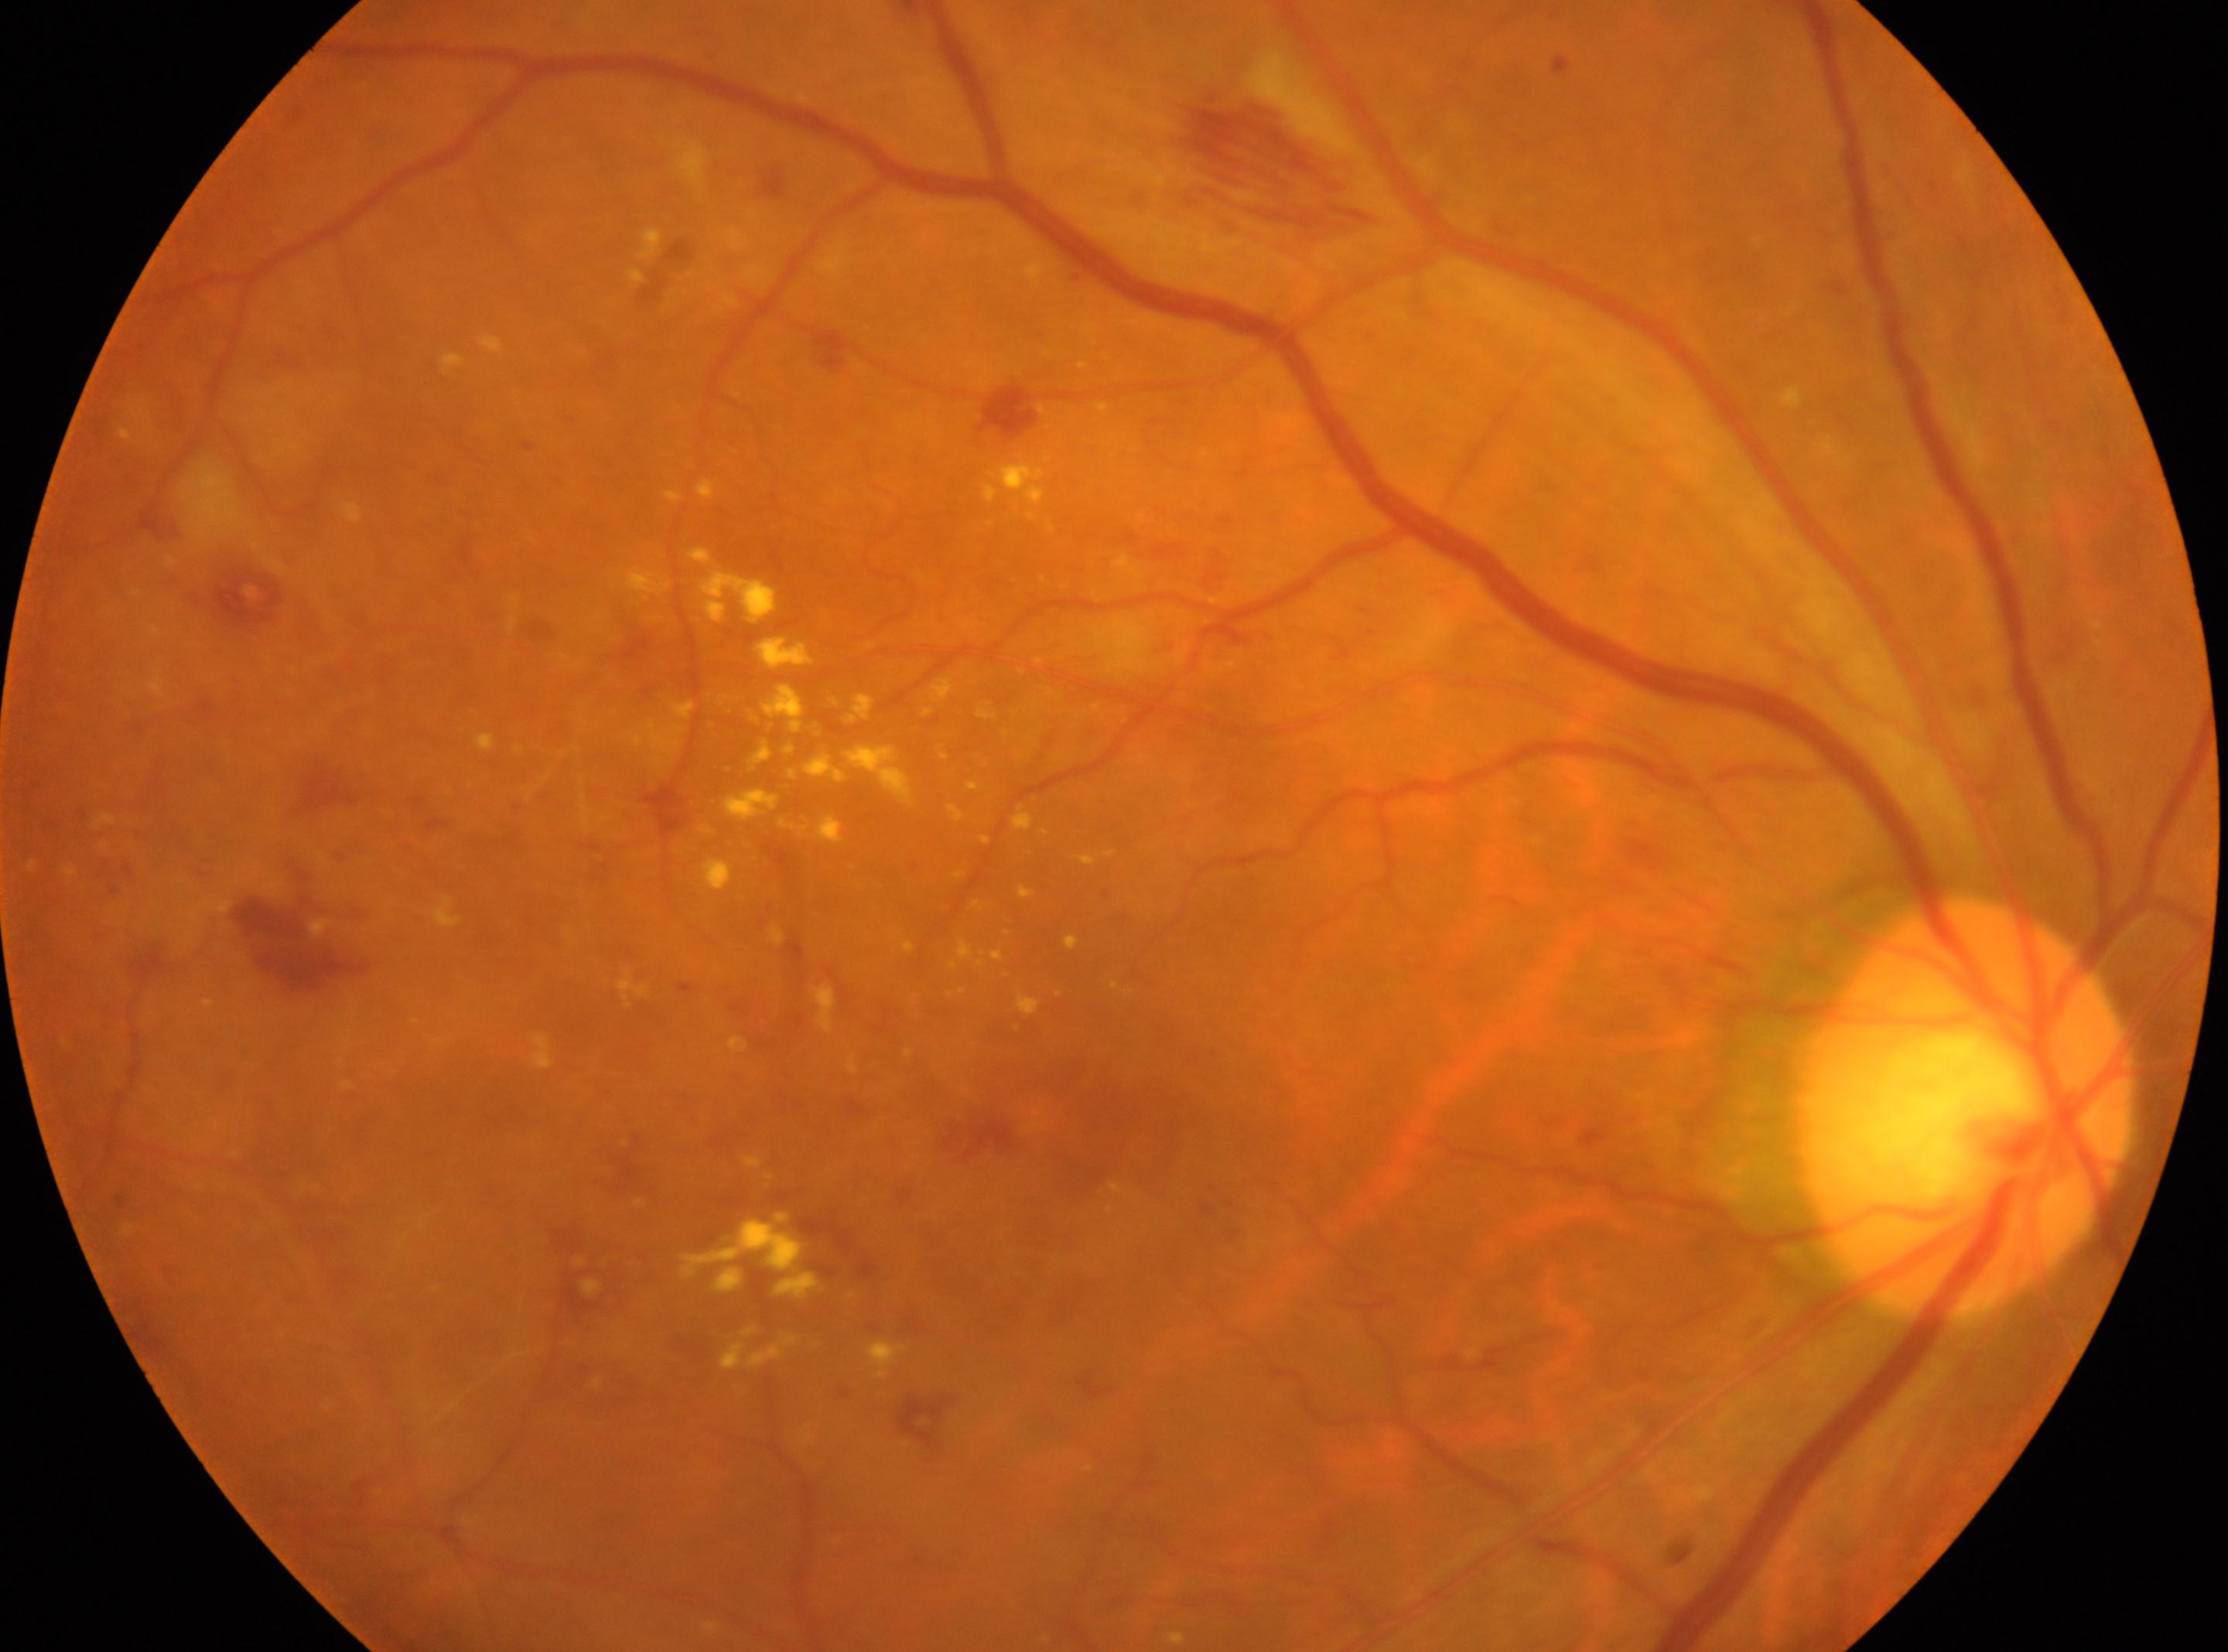 | field | value |
|---|---|
| optic disk | (1962,1106) |
| laterality | the right eye |
| diabetic retinopathy grade | 2 |
| the fovea | (1131,1126) |